FOV: 45 degrees
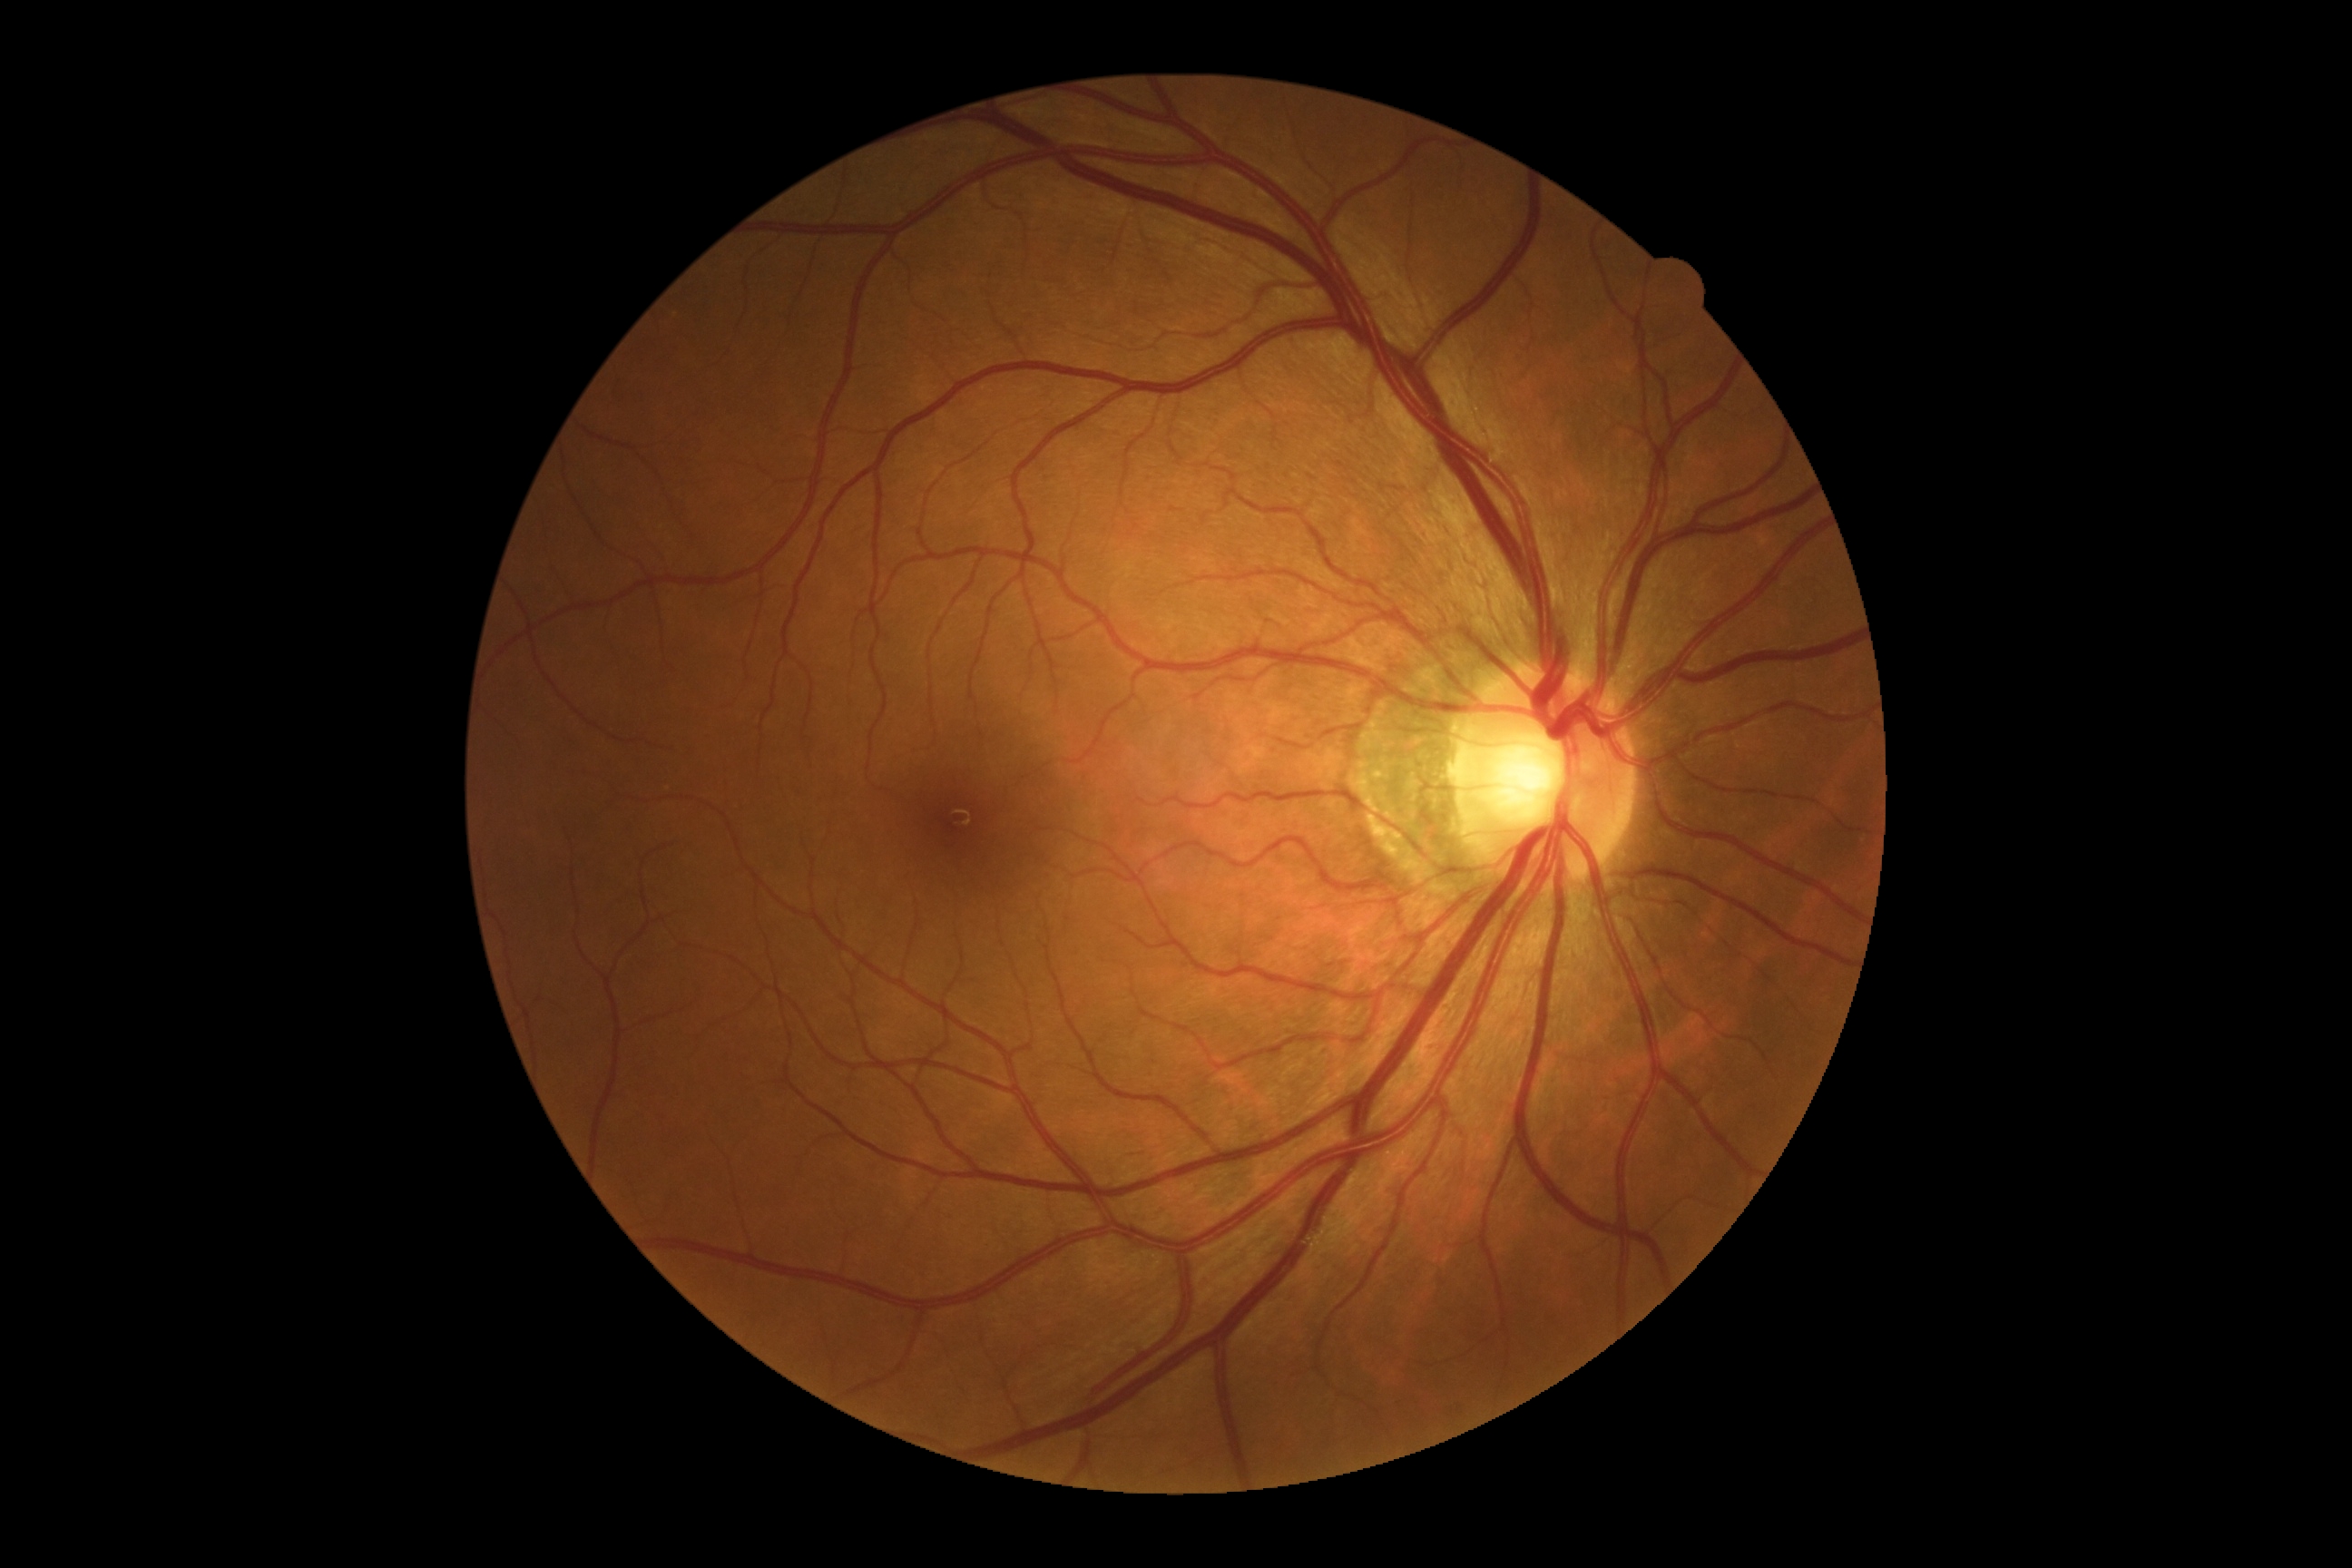

DR is 0/4.